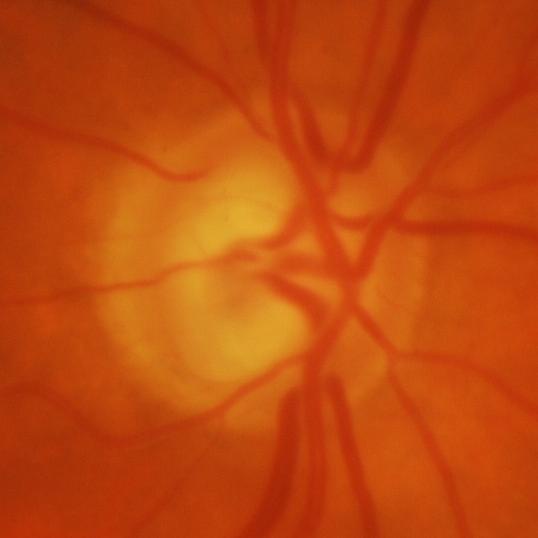

Glaucoma is present. Findings consistent with glaucomatous damage to the optic nerve.